FOV: 45 degrees:
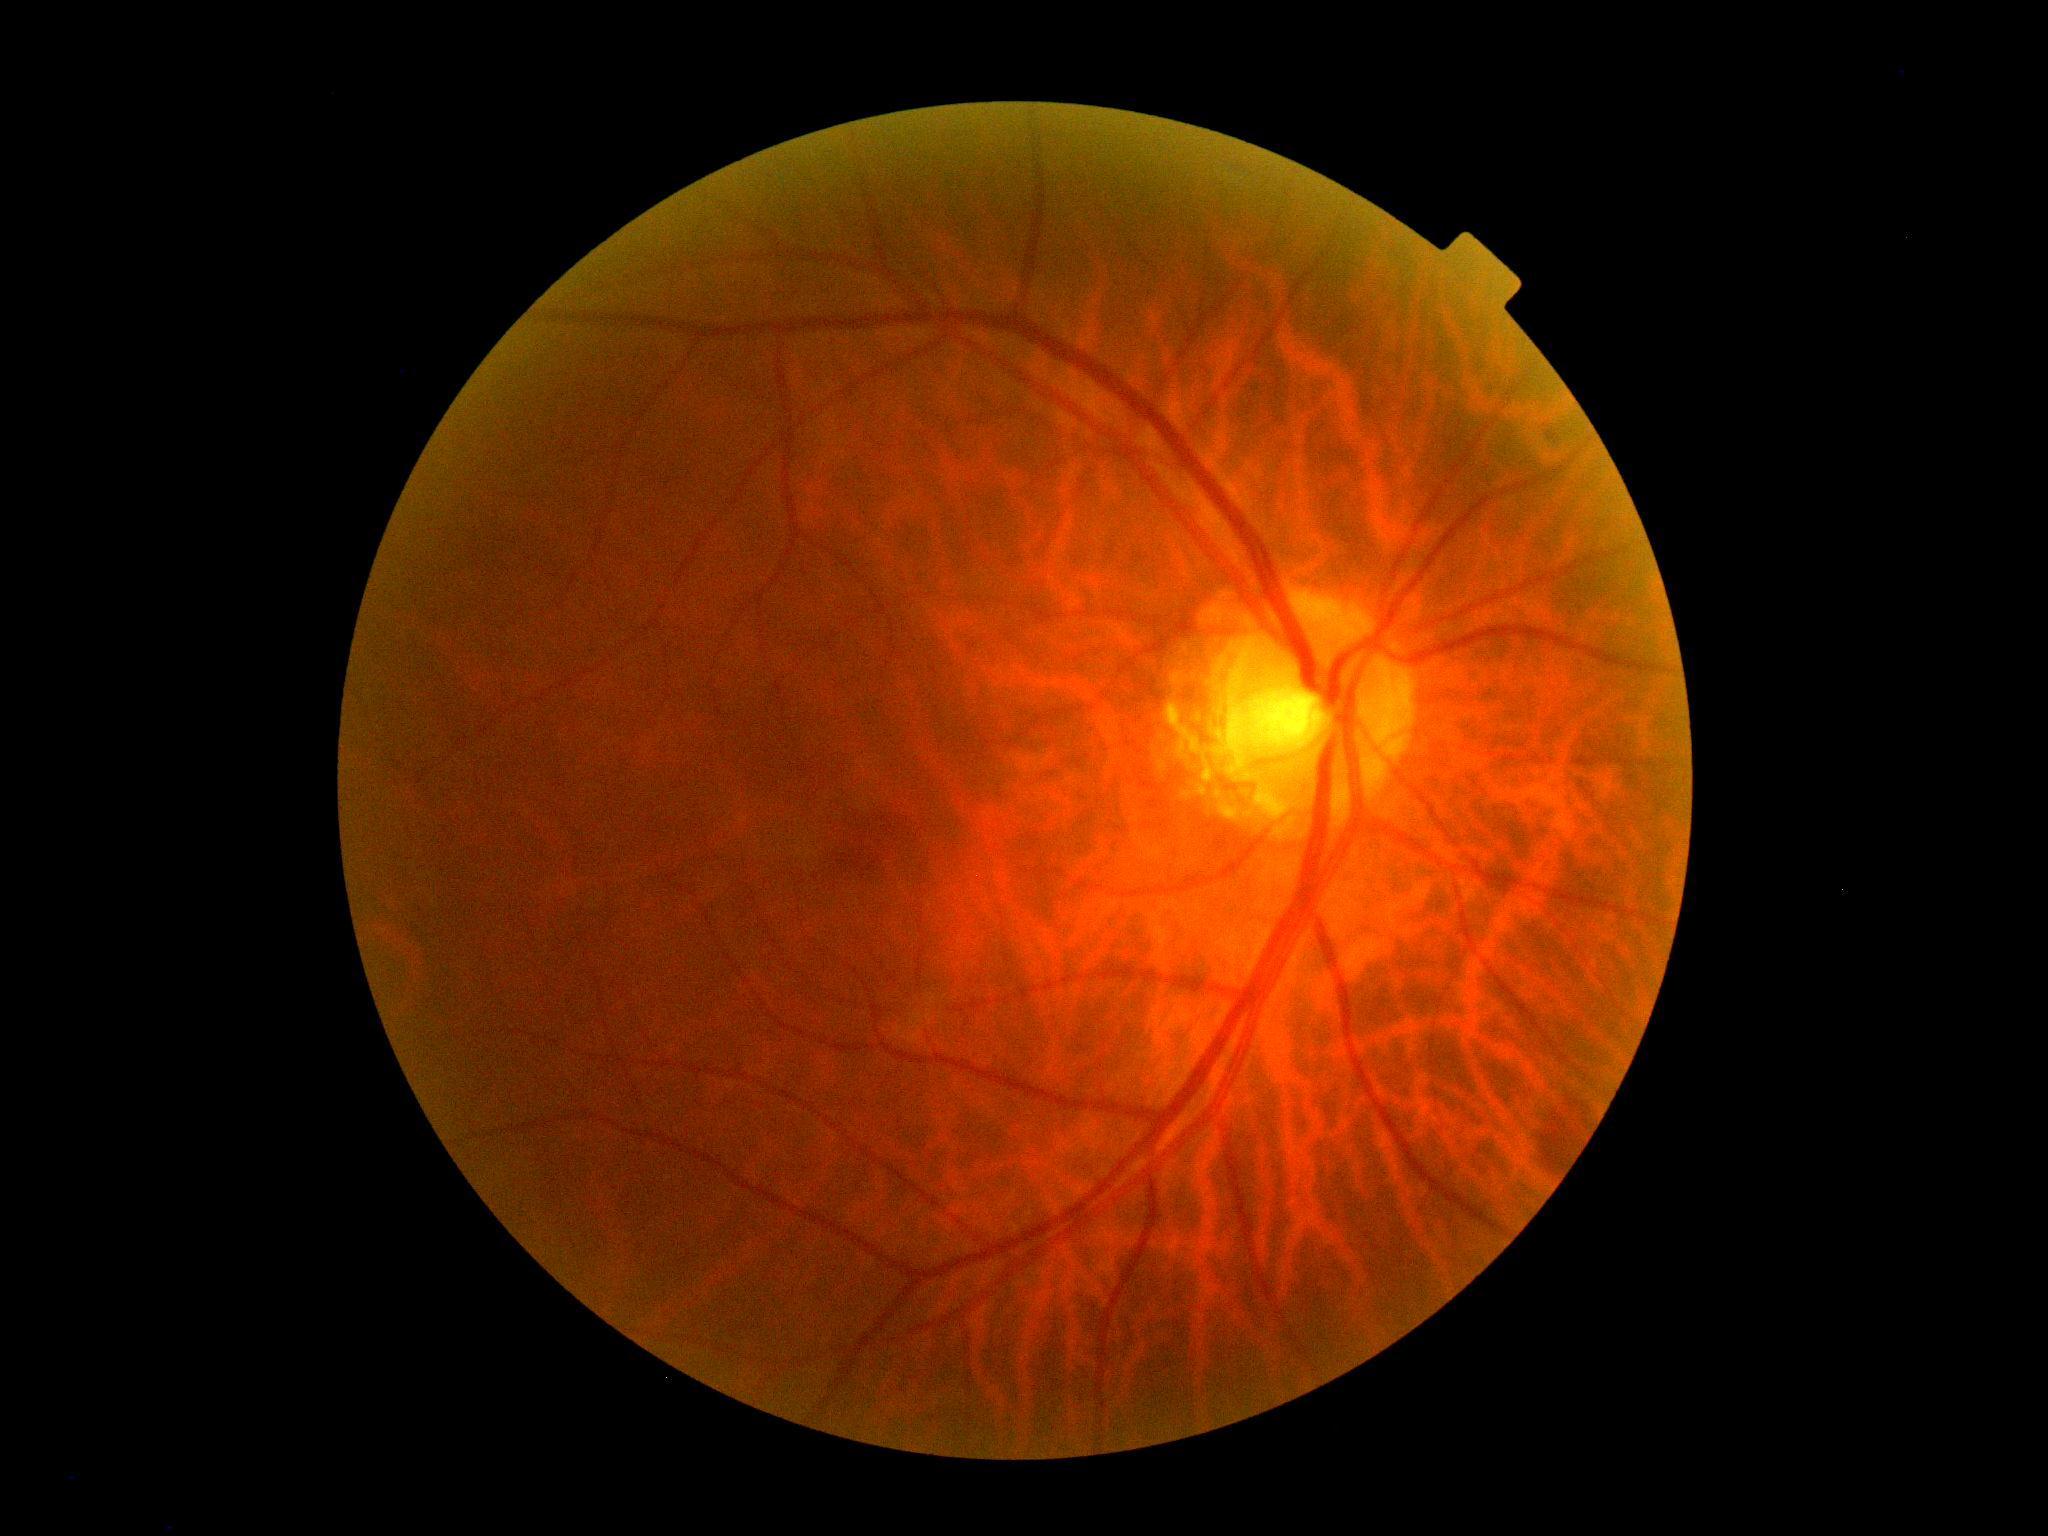 {
  "dr_grade": "0 — no visible signs of diabetic retinopathy",
  "dr_impression": "no signs of DR"
}